1932x1916px, 45° field of view: 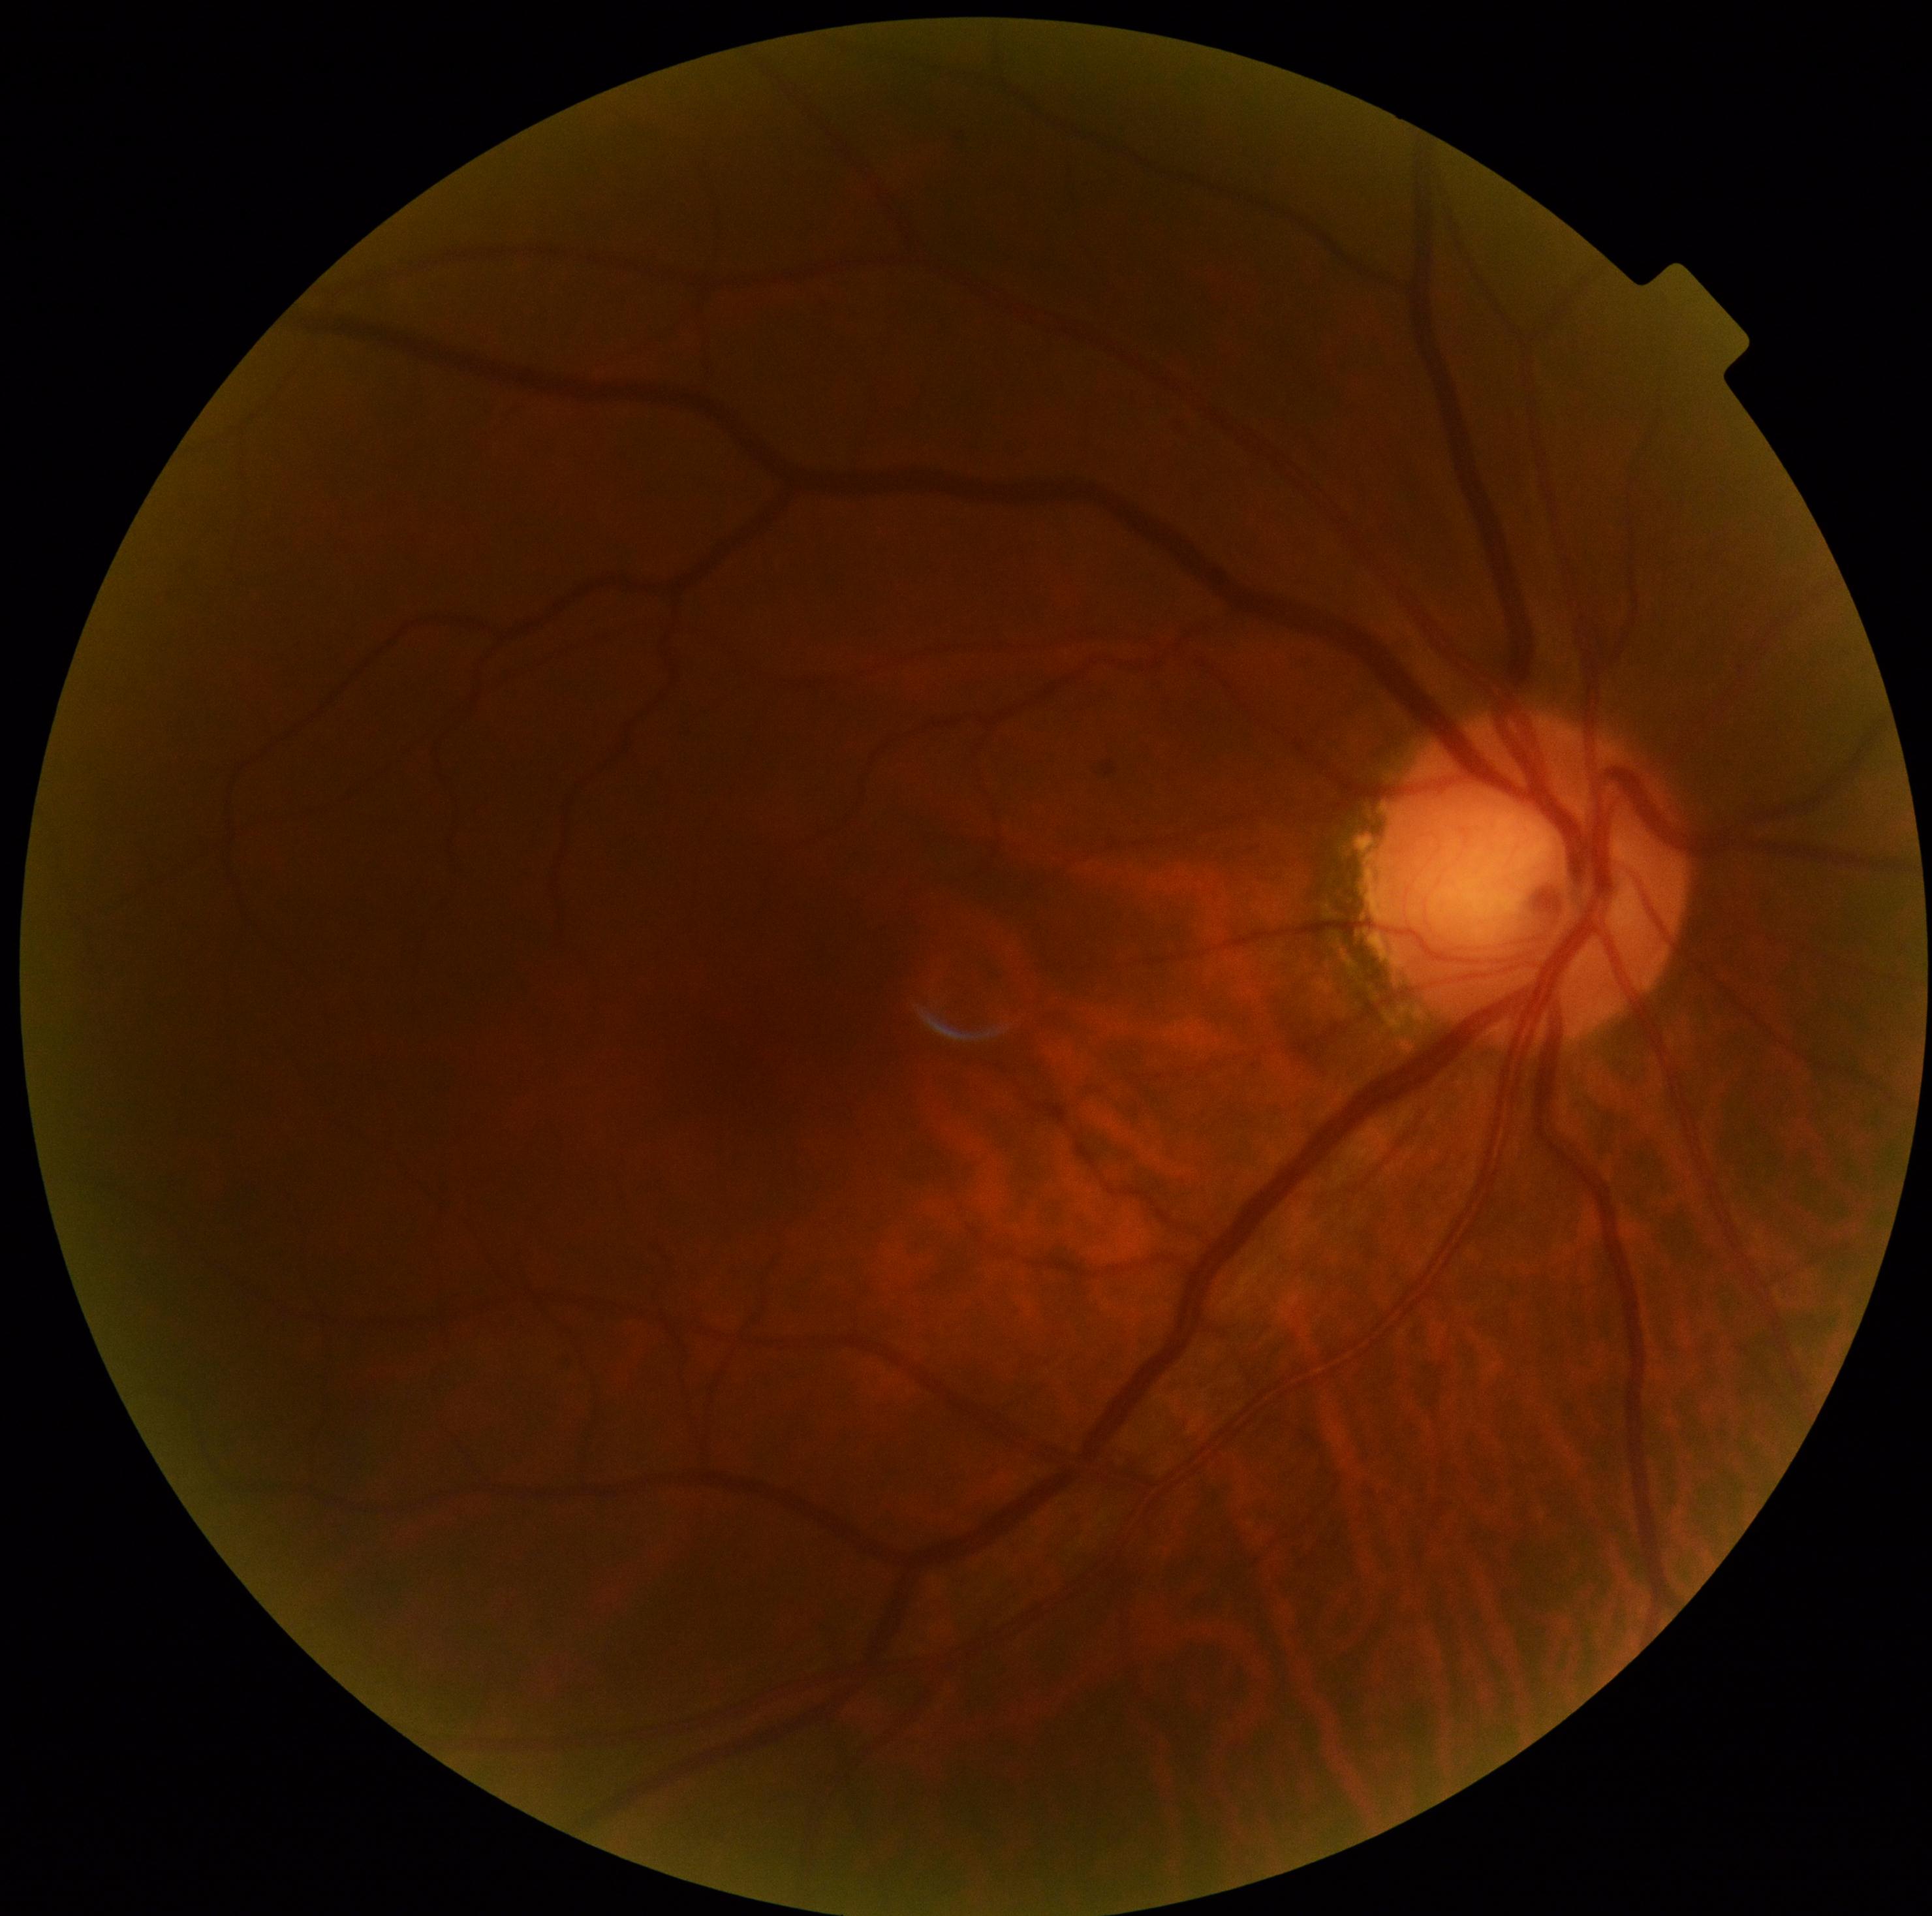
DR is 0.